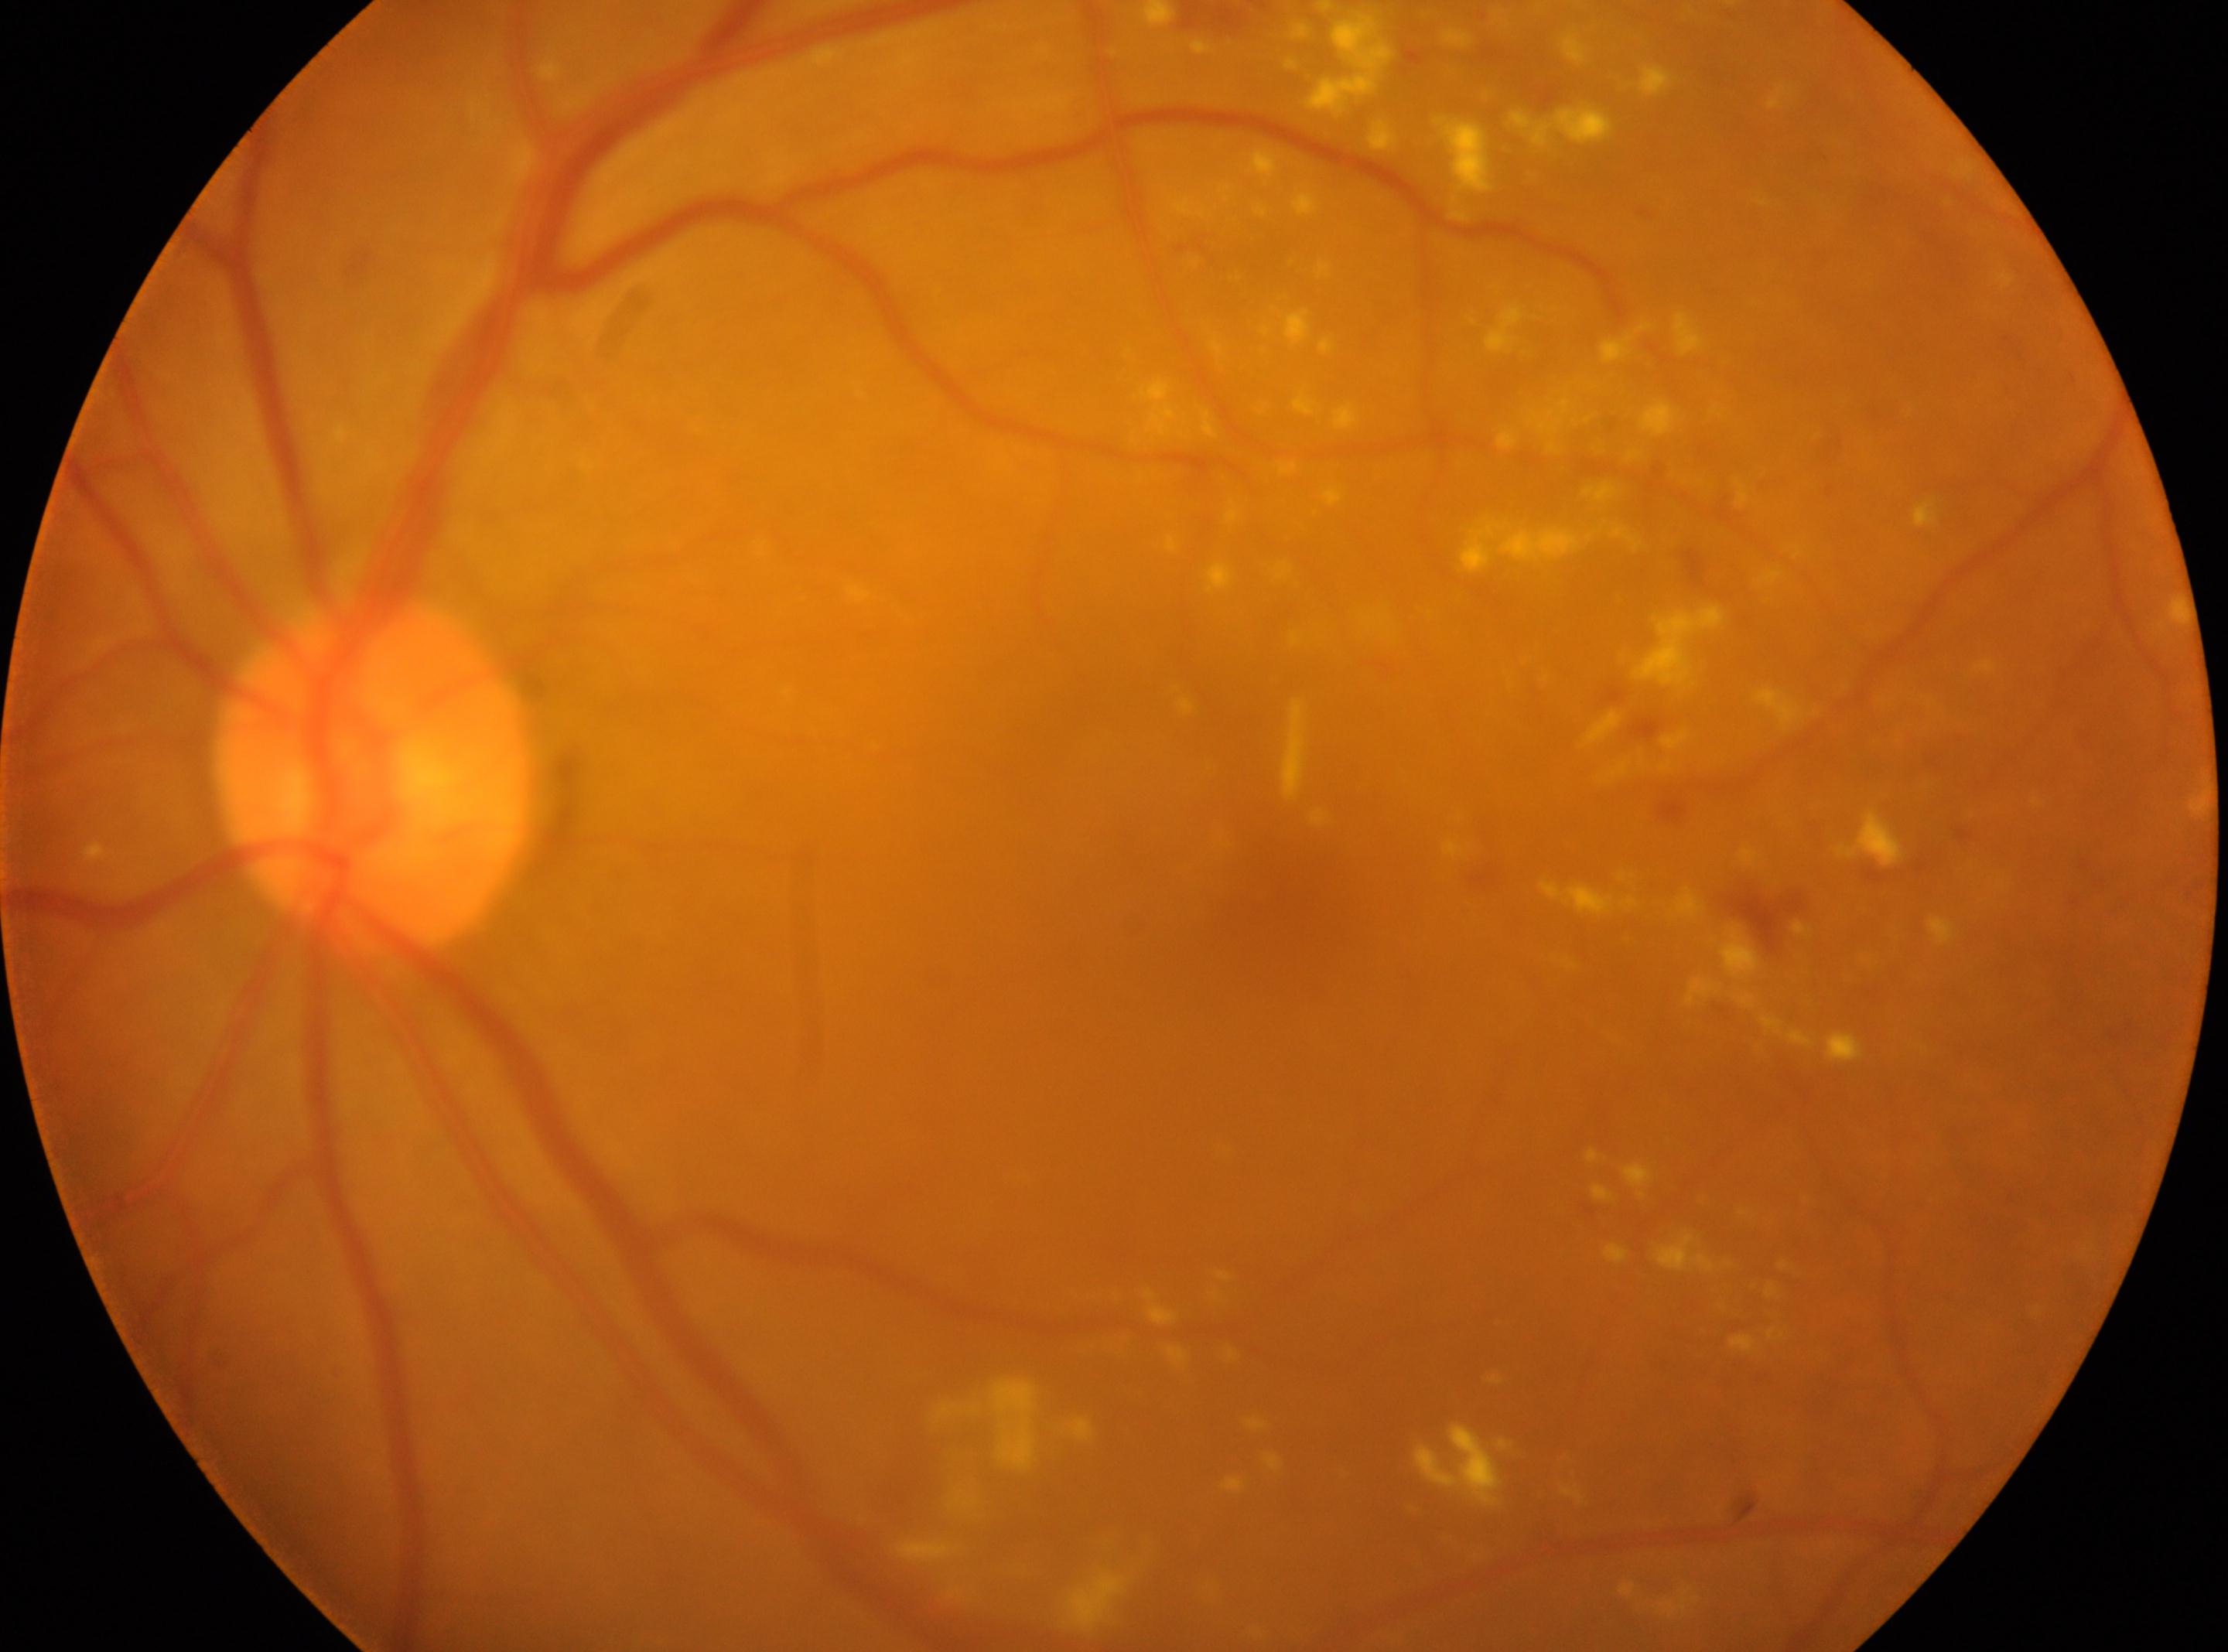 Imaged eye: oculus sinister. Fovea center located at (1263,894). DR grade is 2/4. The optic disc is at (379,775).